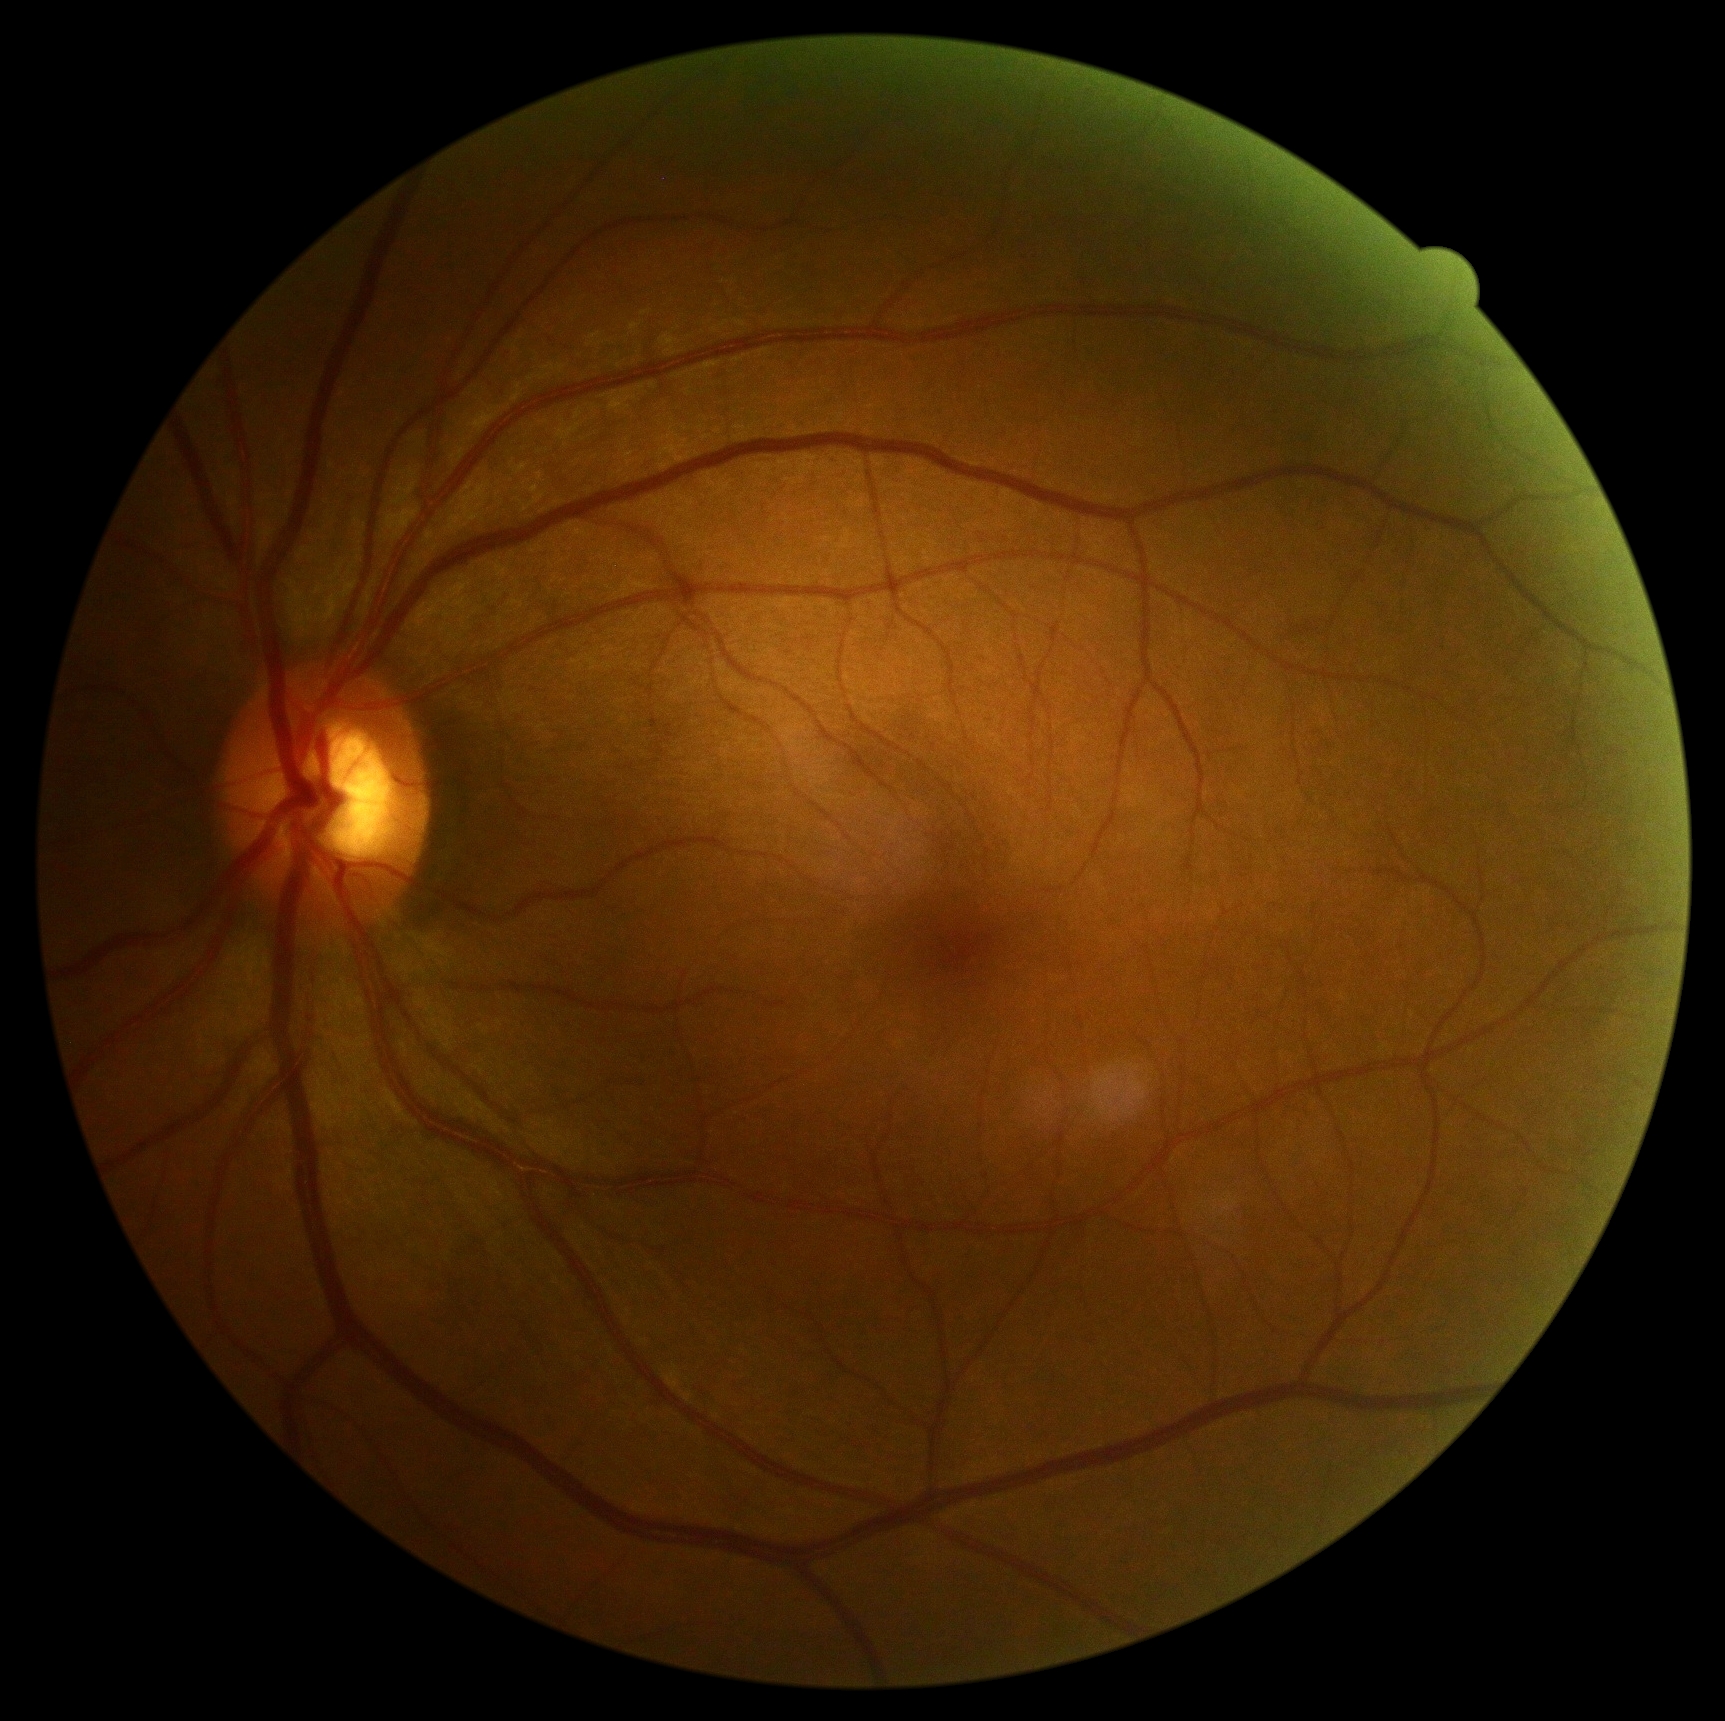

DR grade: no apparent retinopathy (0).